848x848px
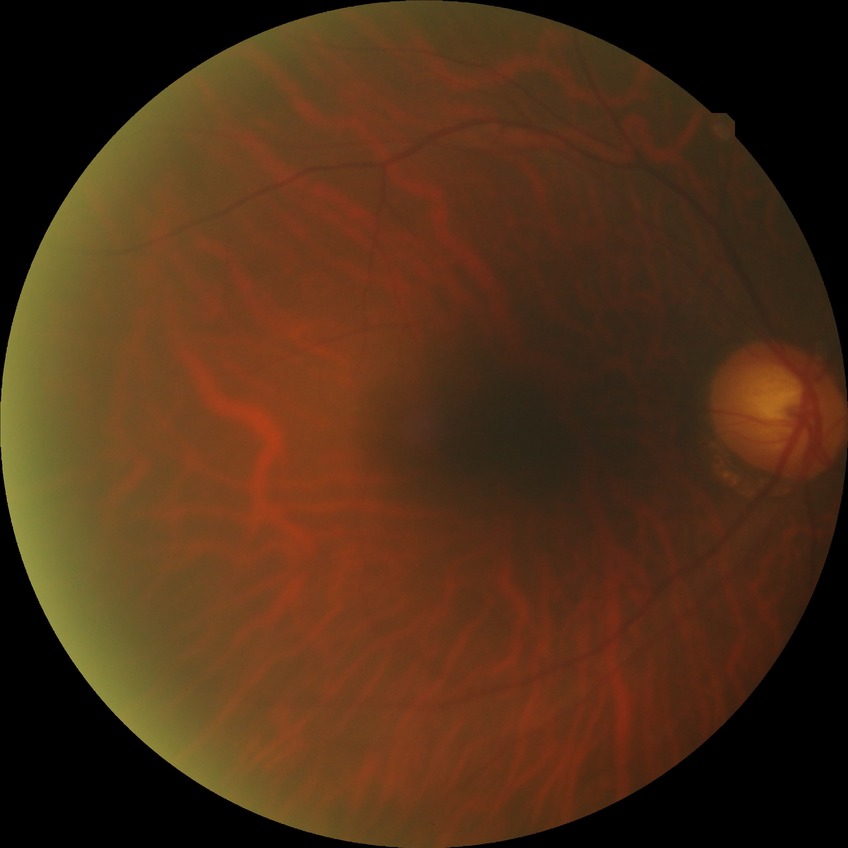 davis_grade: NDR (no diabetic retinopathy)